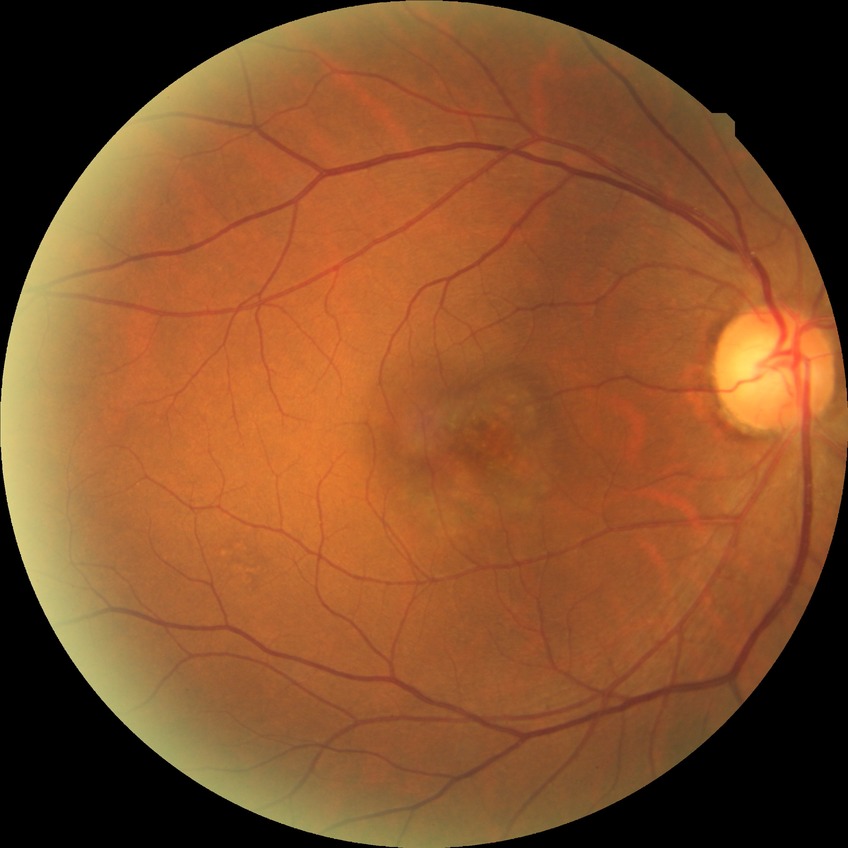
{
  "davis_grade": "no diabetic retinopathy (NDR)"
}